Wide-field fundus photograph of an infant; 640 by 480 pixels; camera: Clarity RetCam 3 (130° FOV).
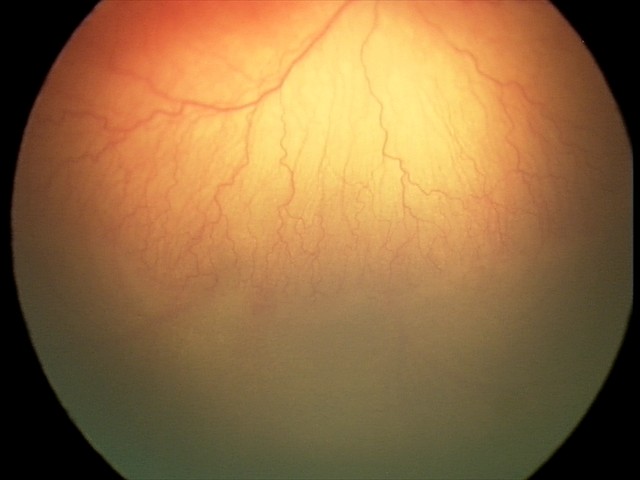 Impression = aggressive retinopathy of prematurity (A-ROP).